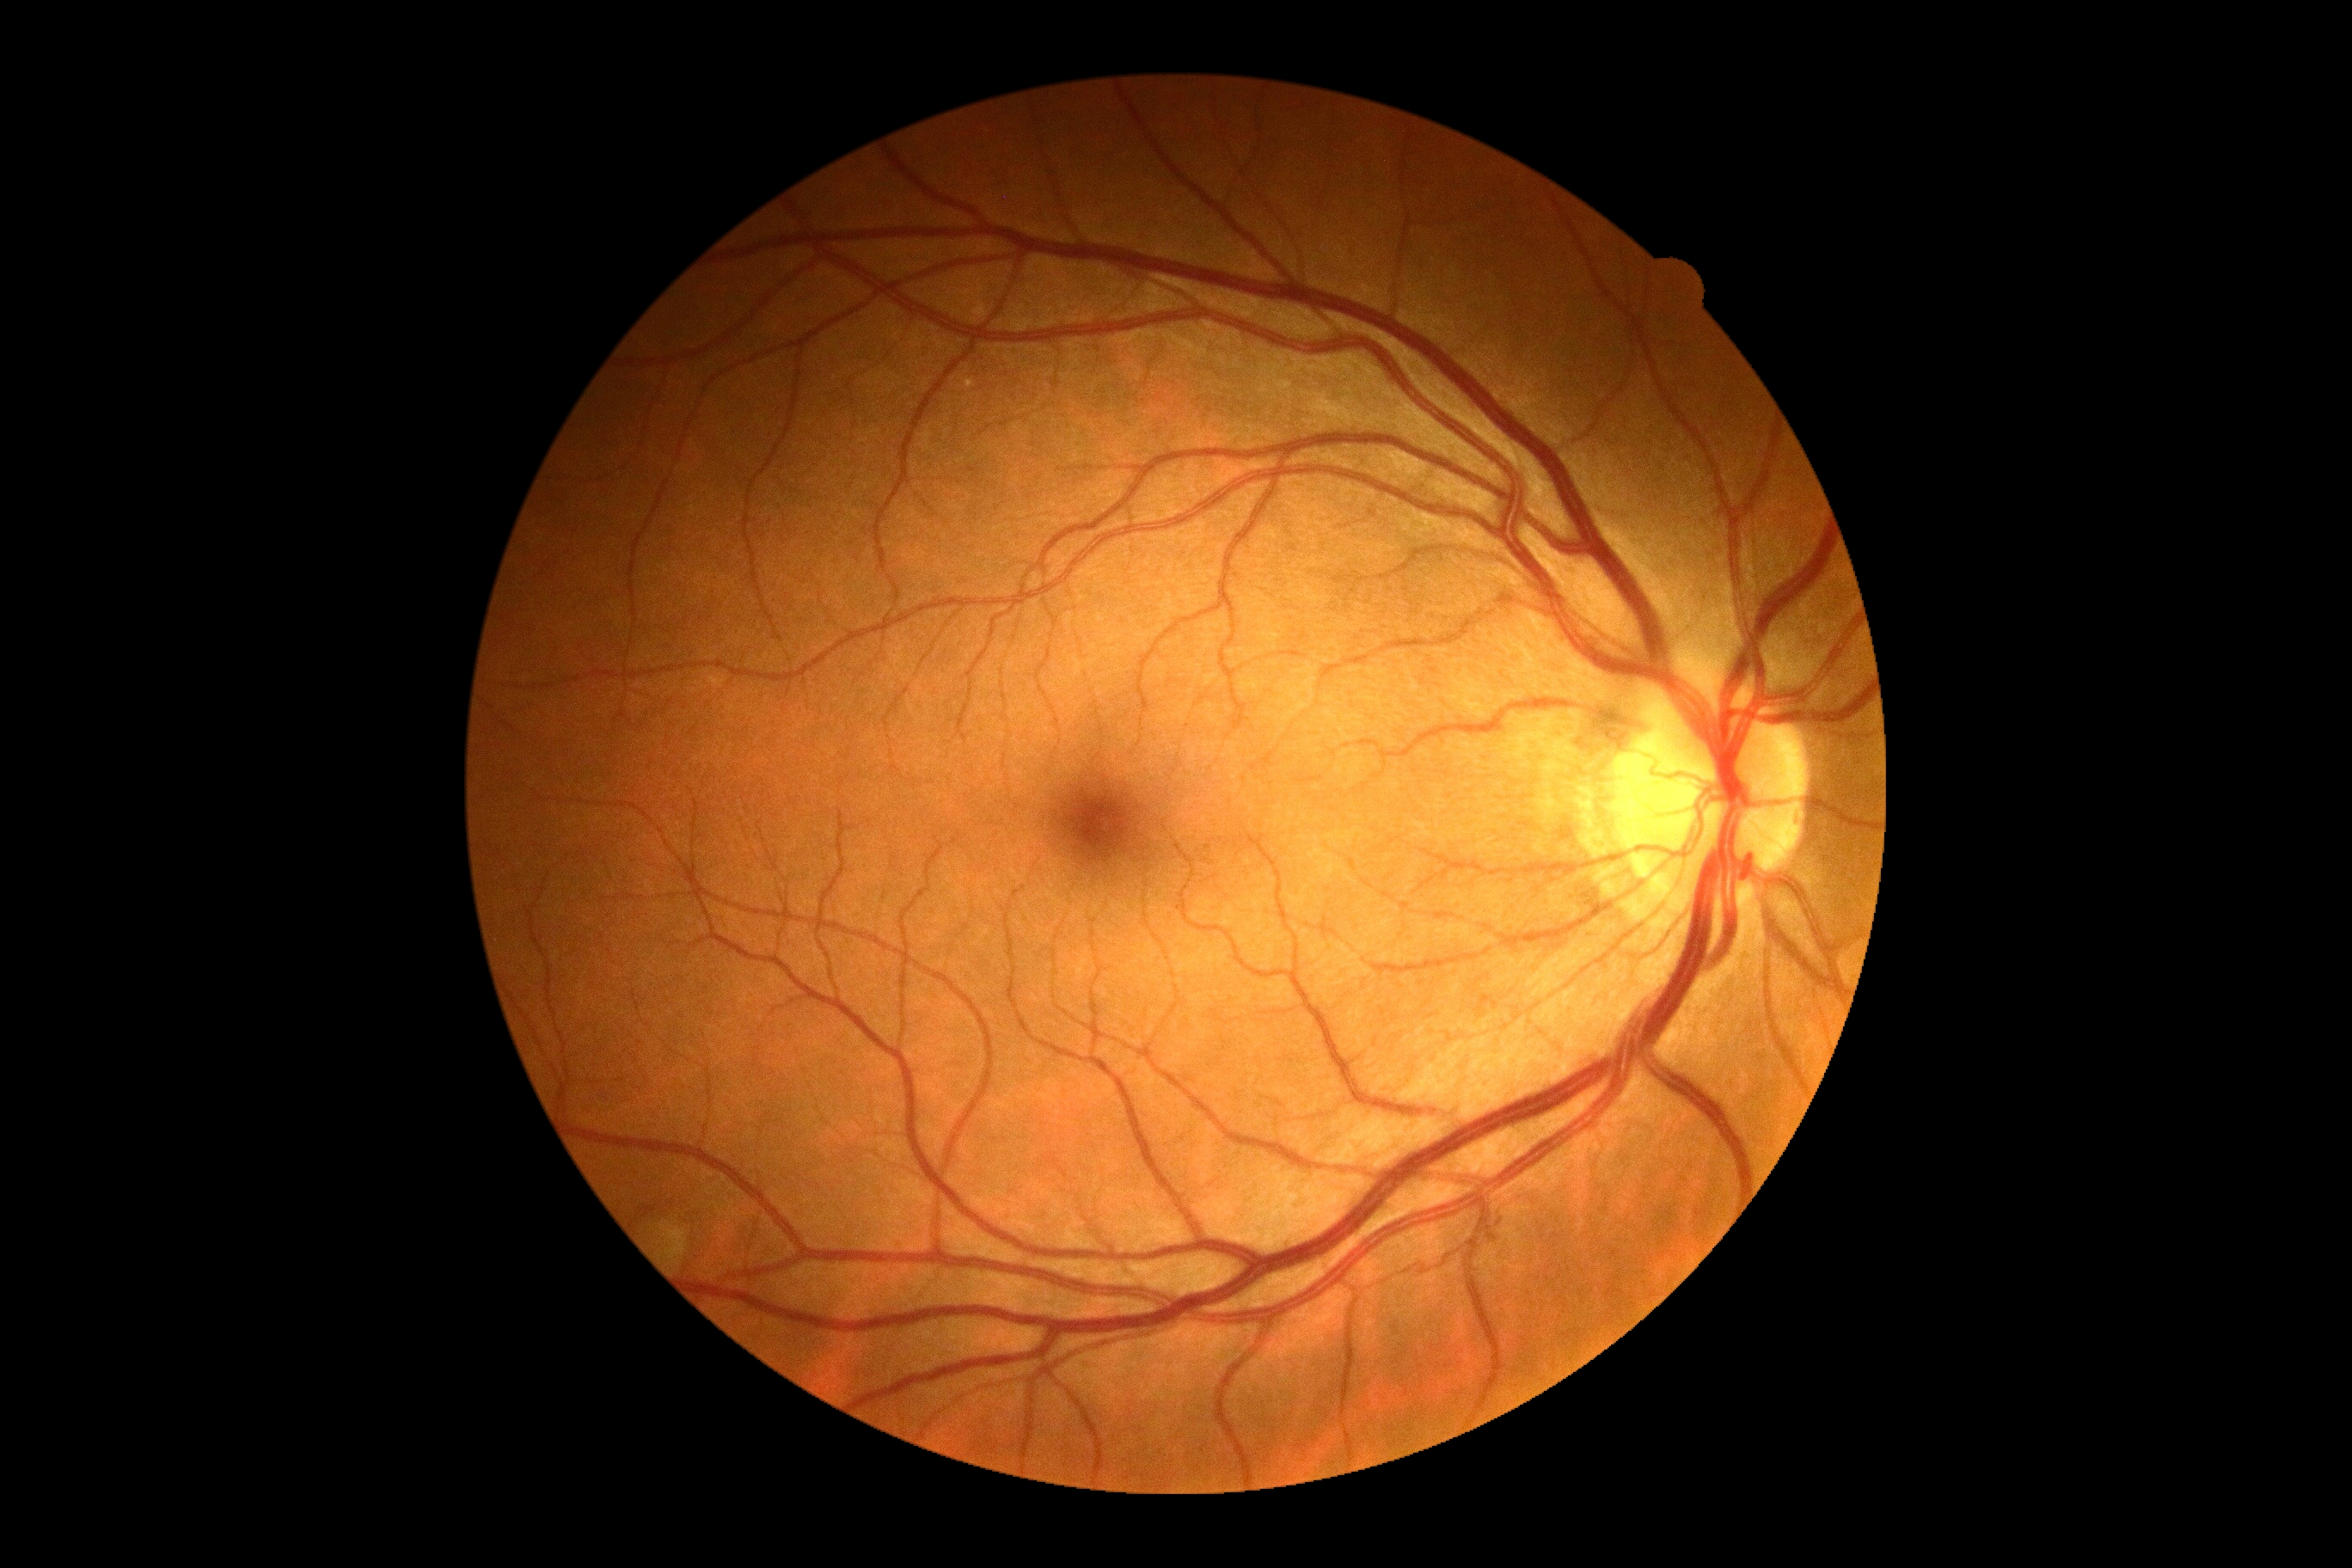 DR=grade 0 (no apparent retinopathy).